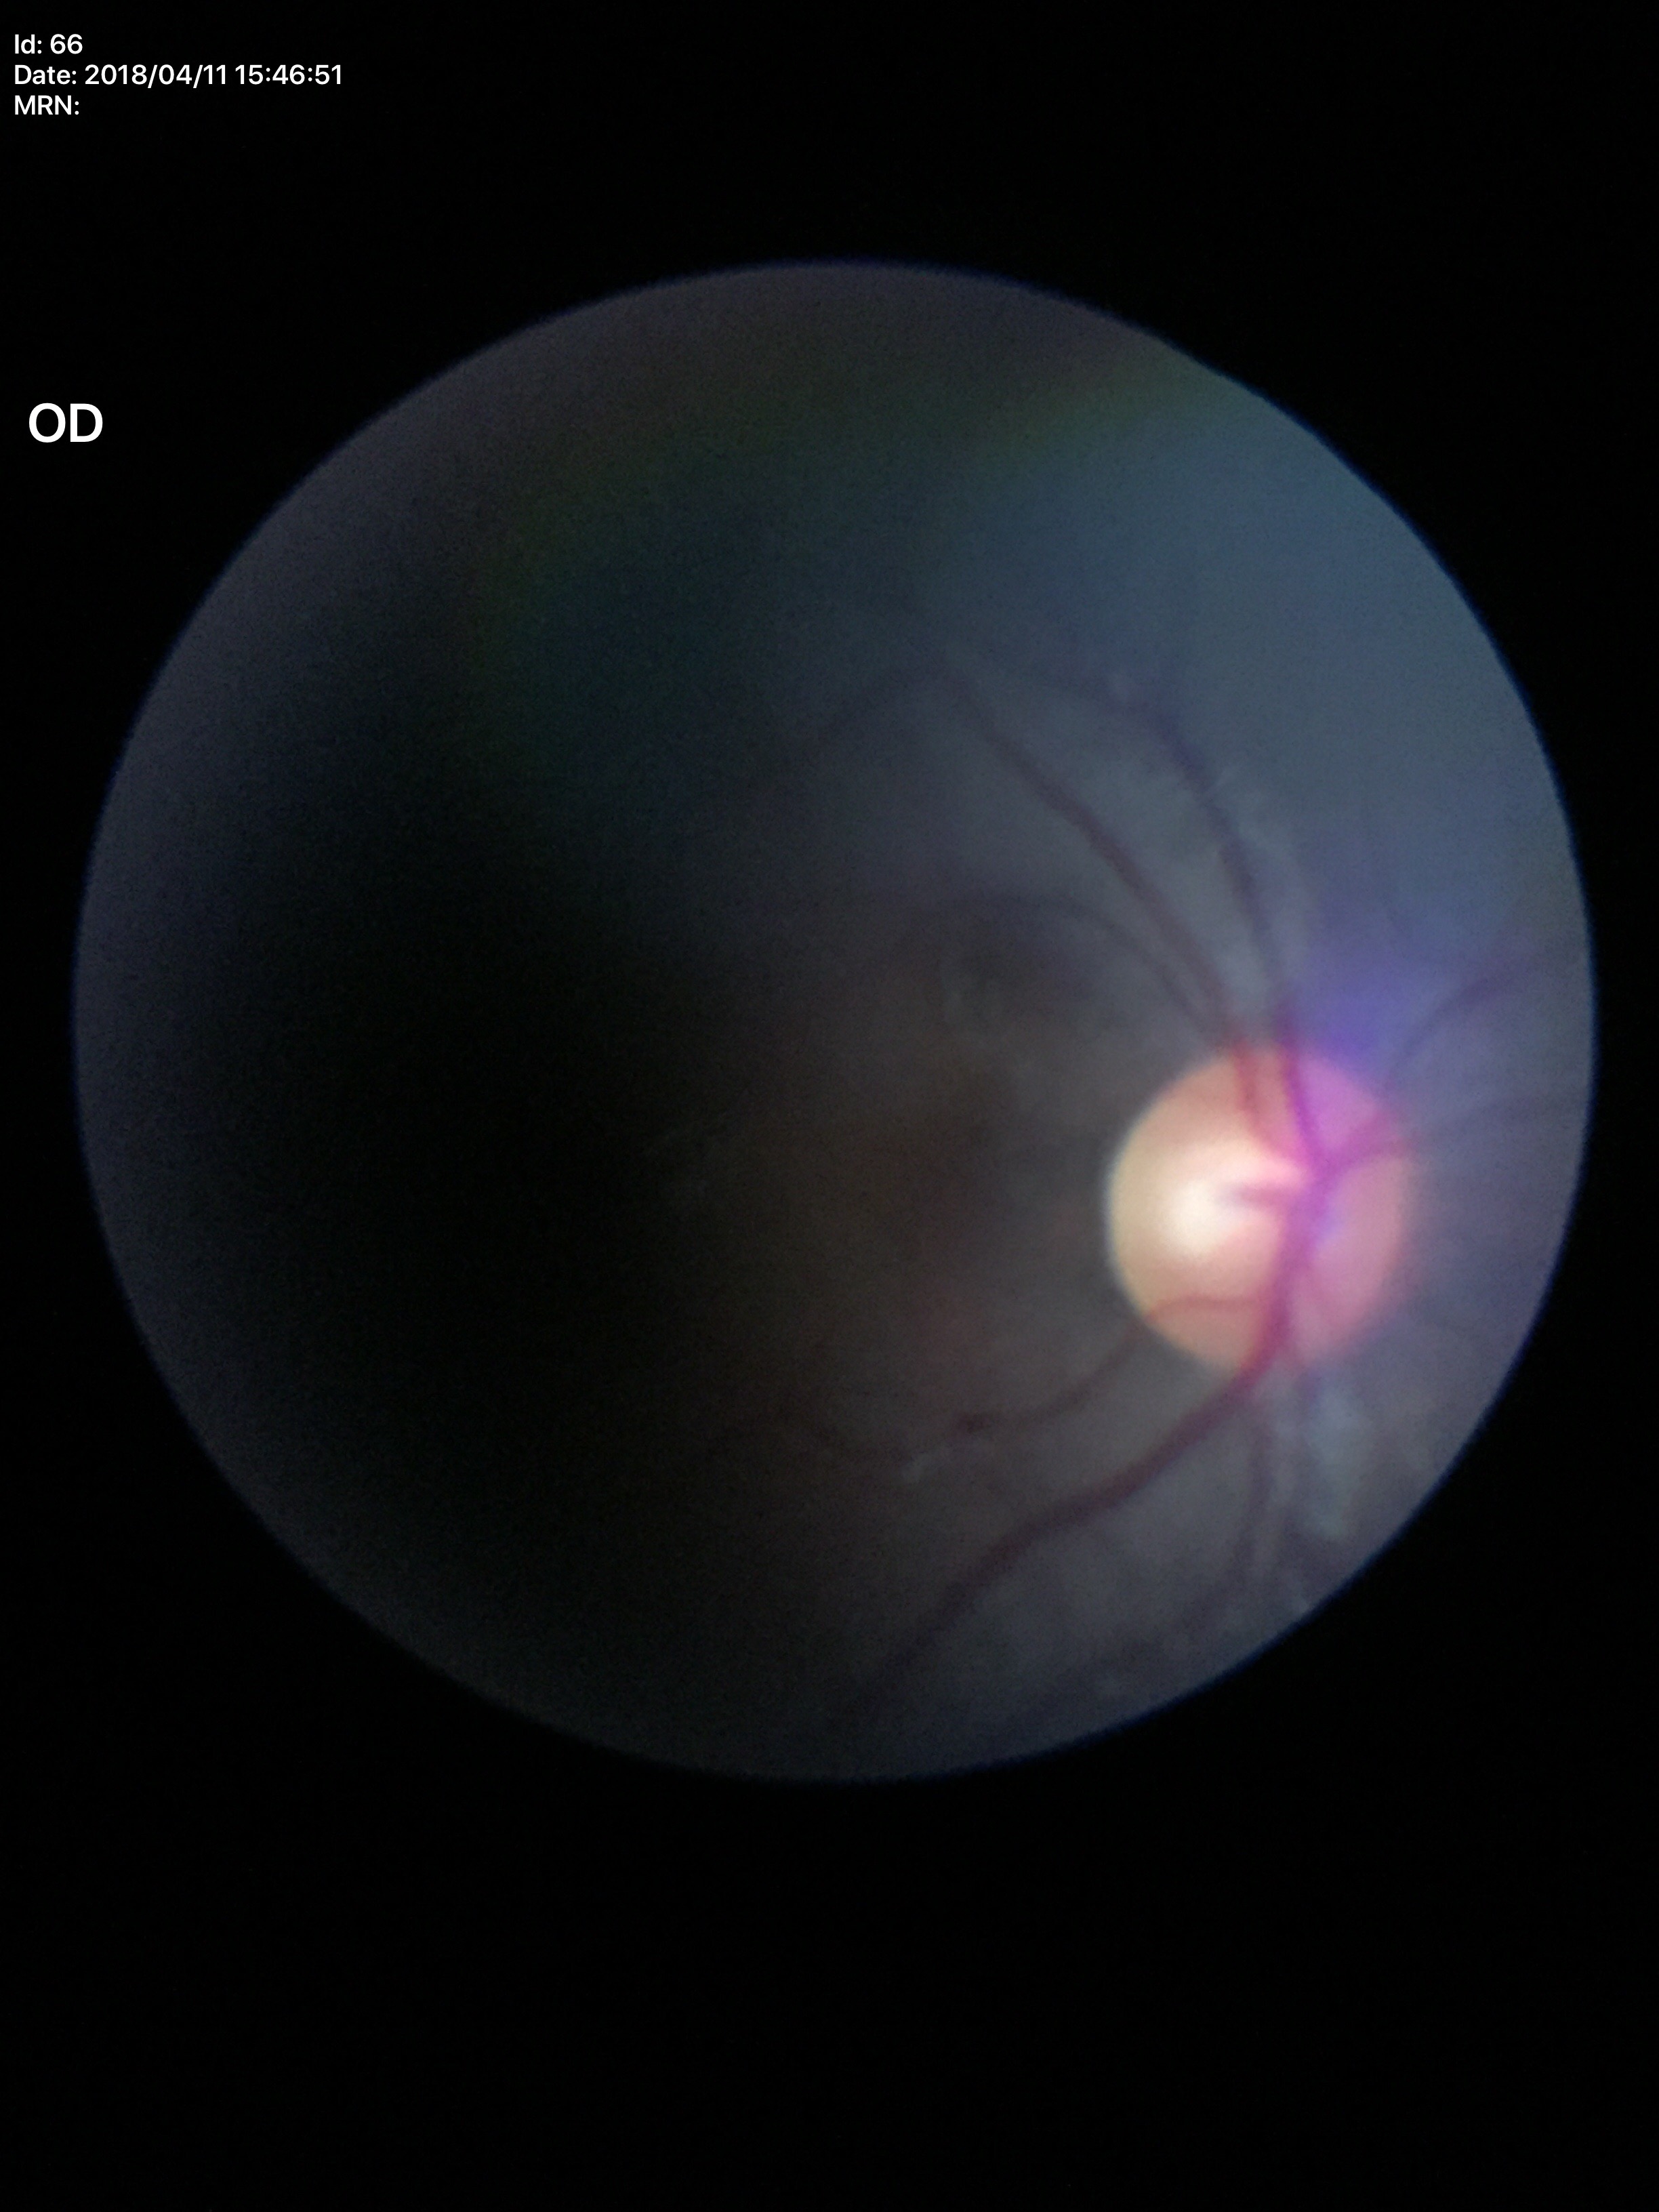

Glaucoma screening: negative.
Vertical cup-disc ratio is 0.53.